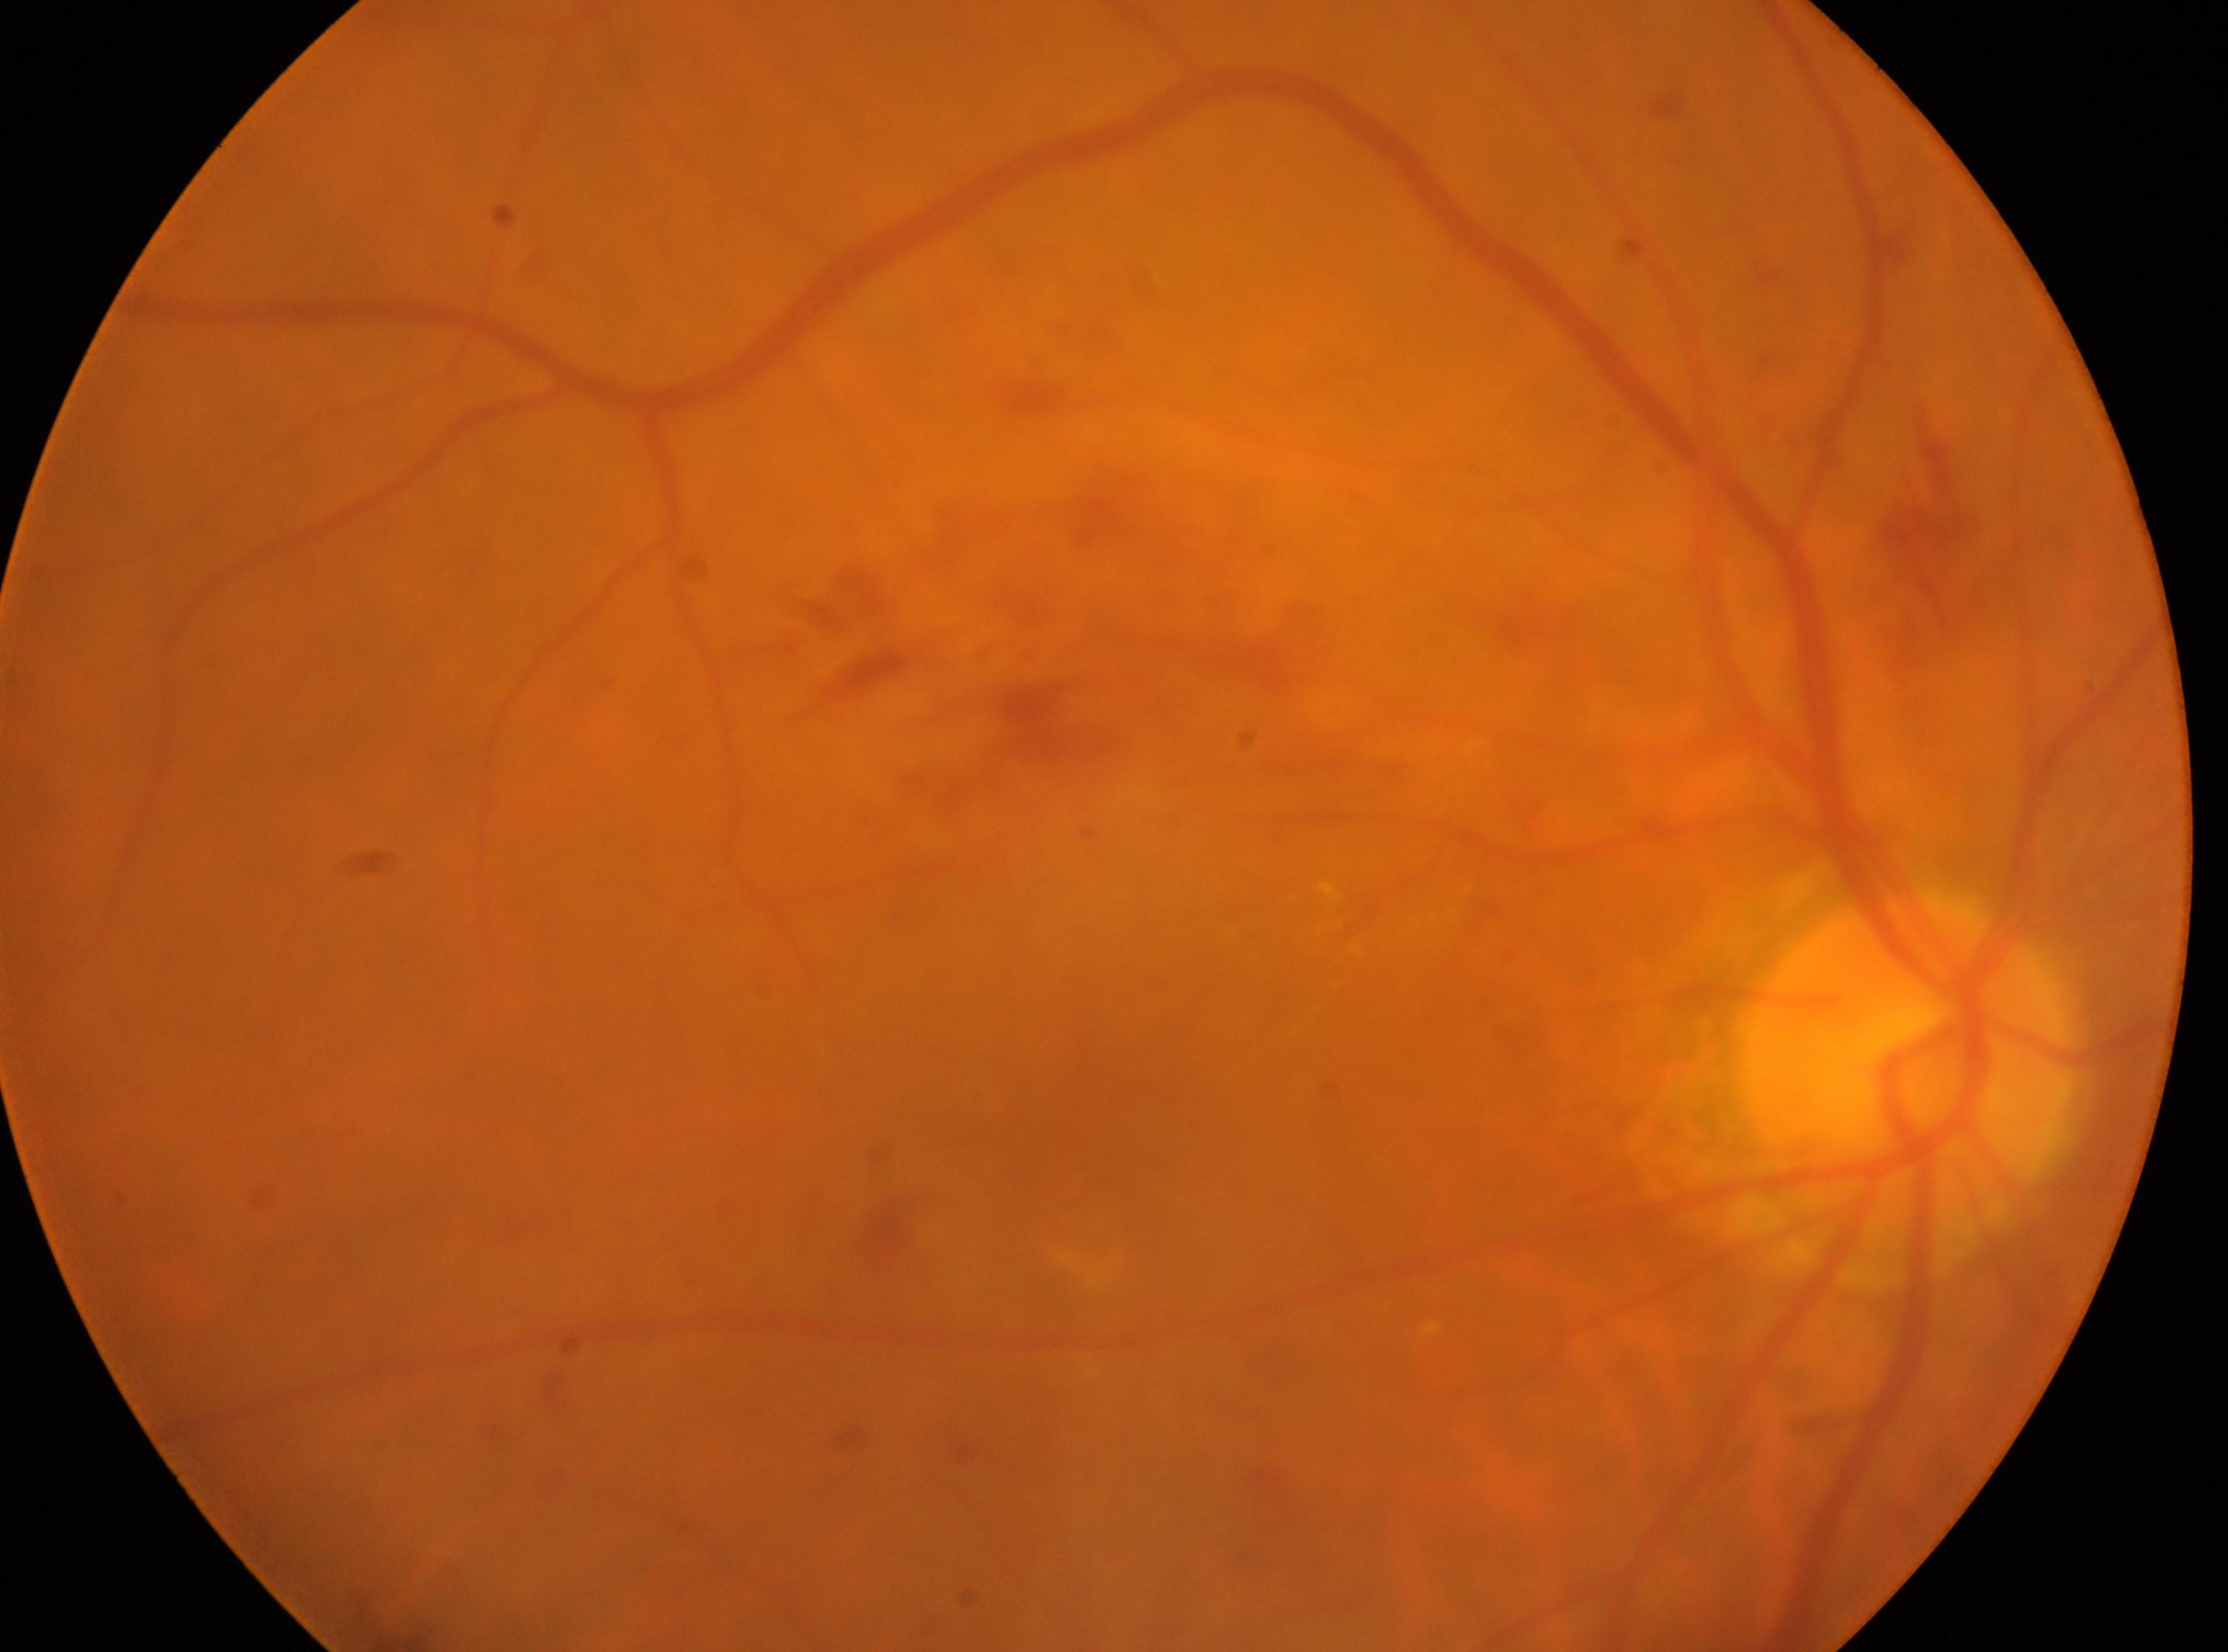

Optic disc: 1902, 1063.
The macular center is at 1072, 1067.
Diabetic retinopathy severity: 2.
Imaged eye: OD.